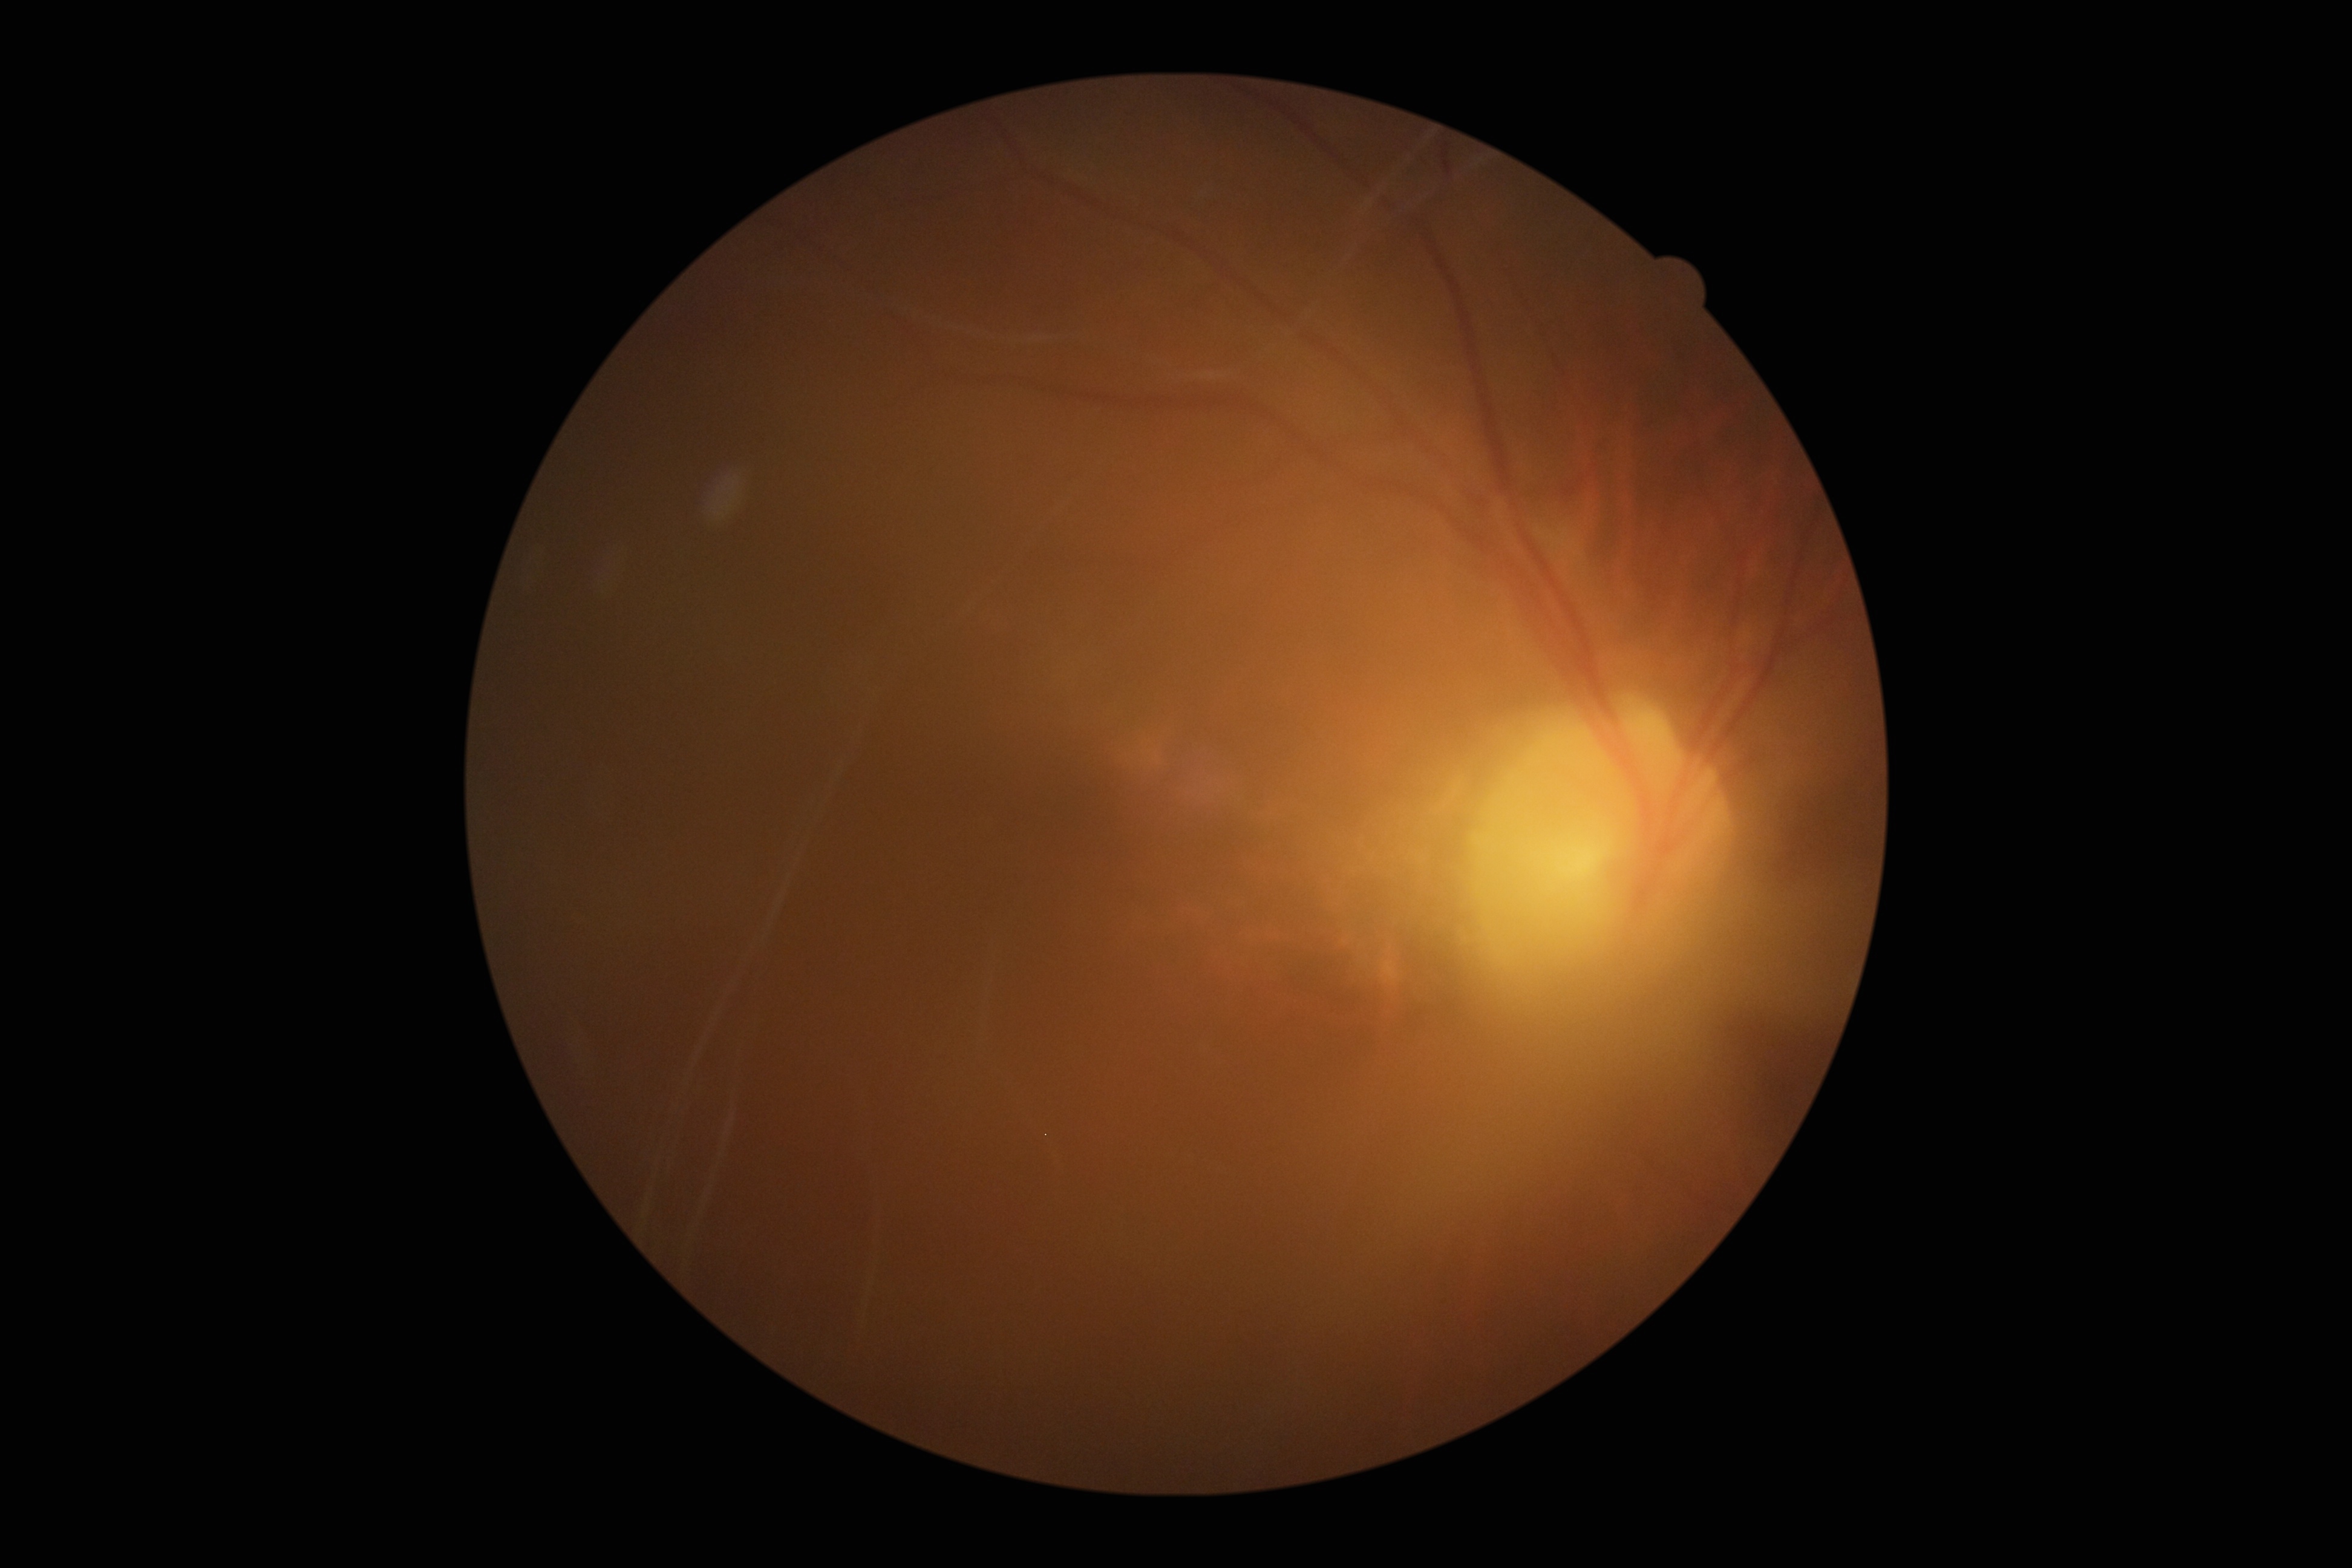

DR severity=ungradable due to poor image quality; image quality=insufficient.